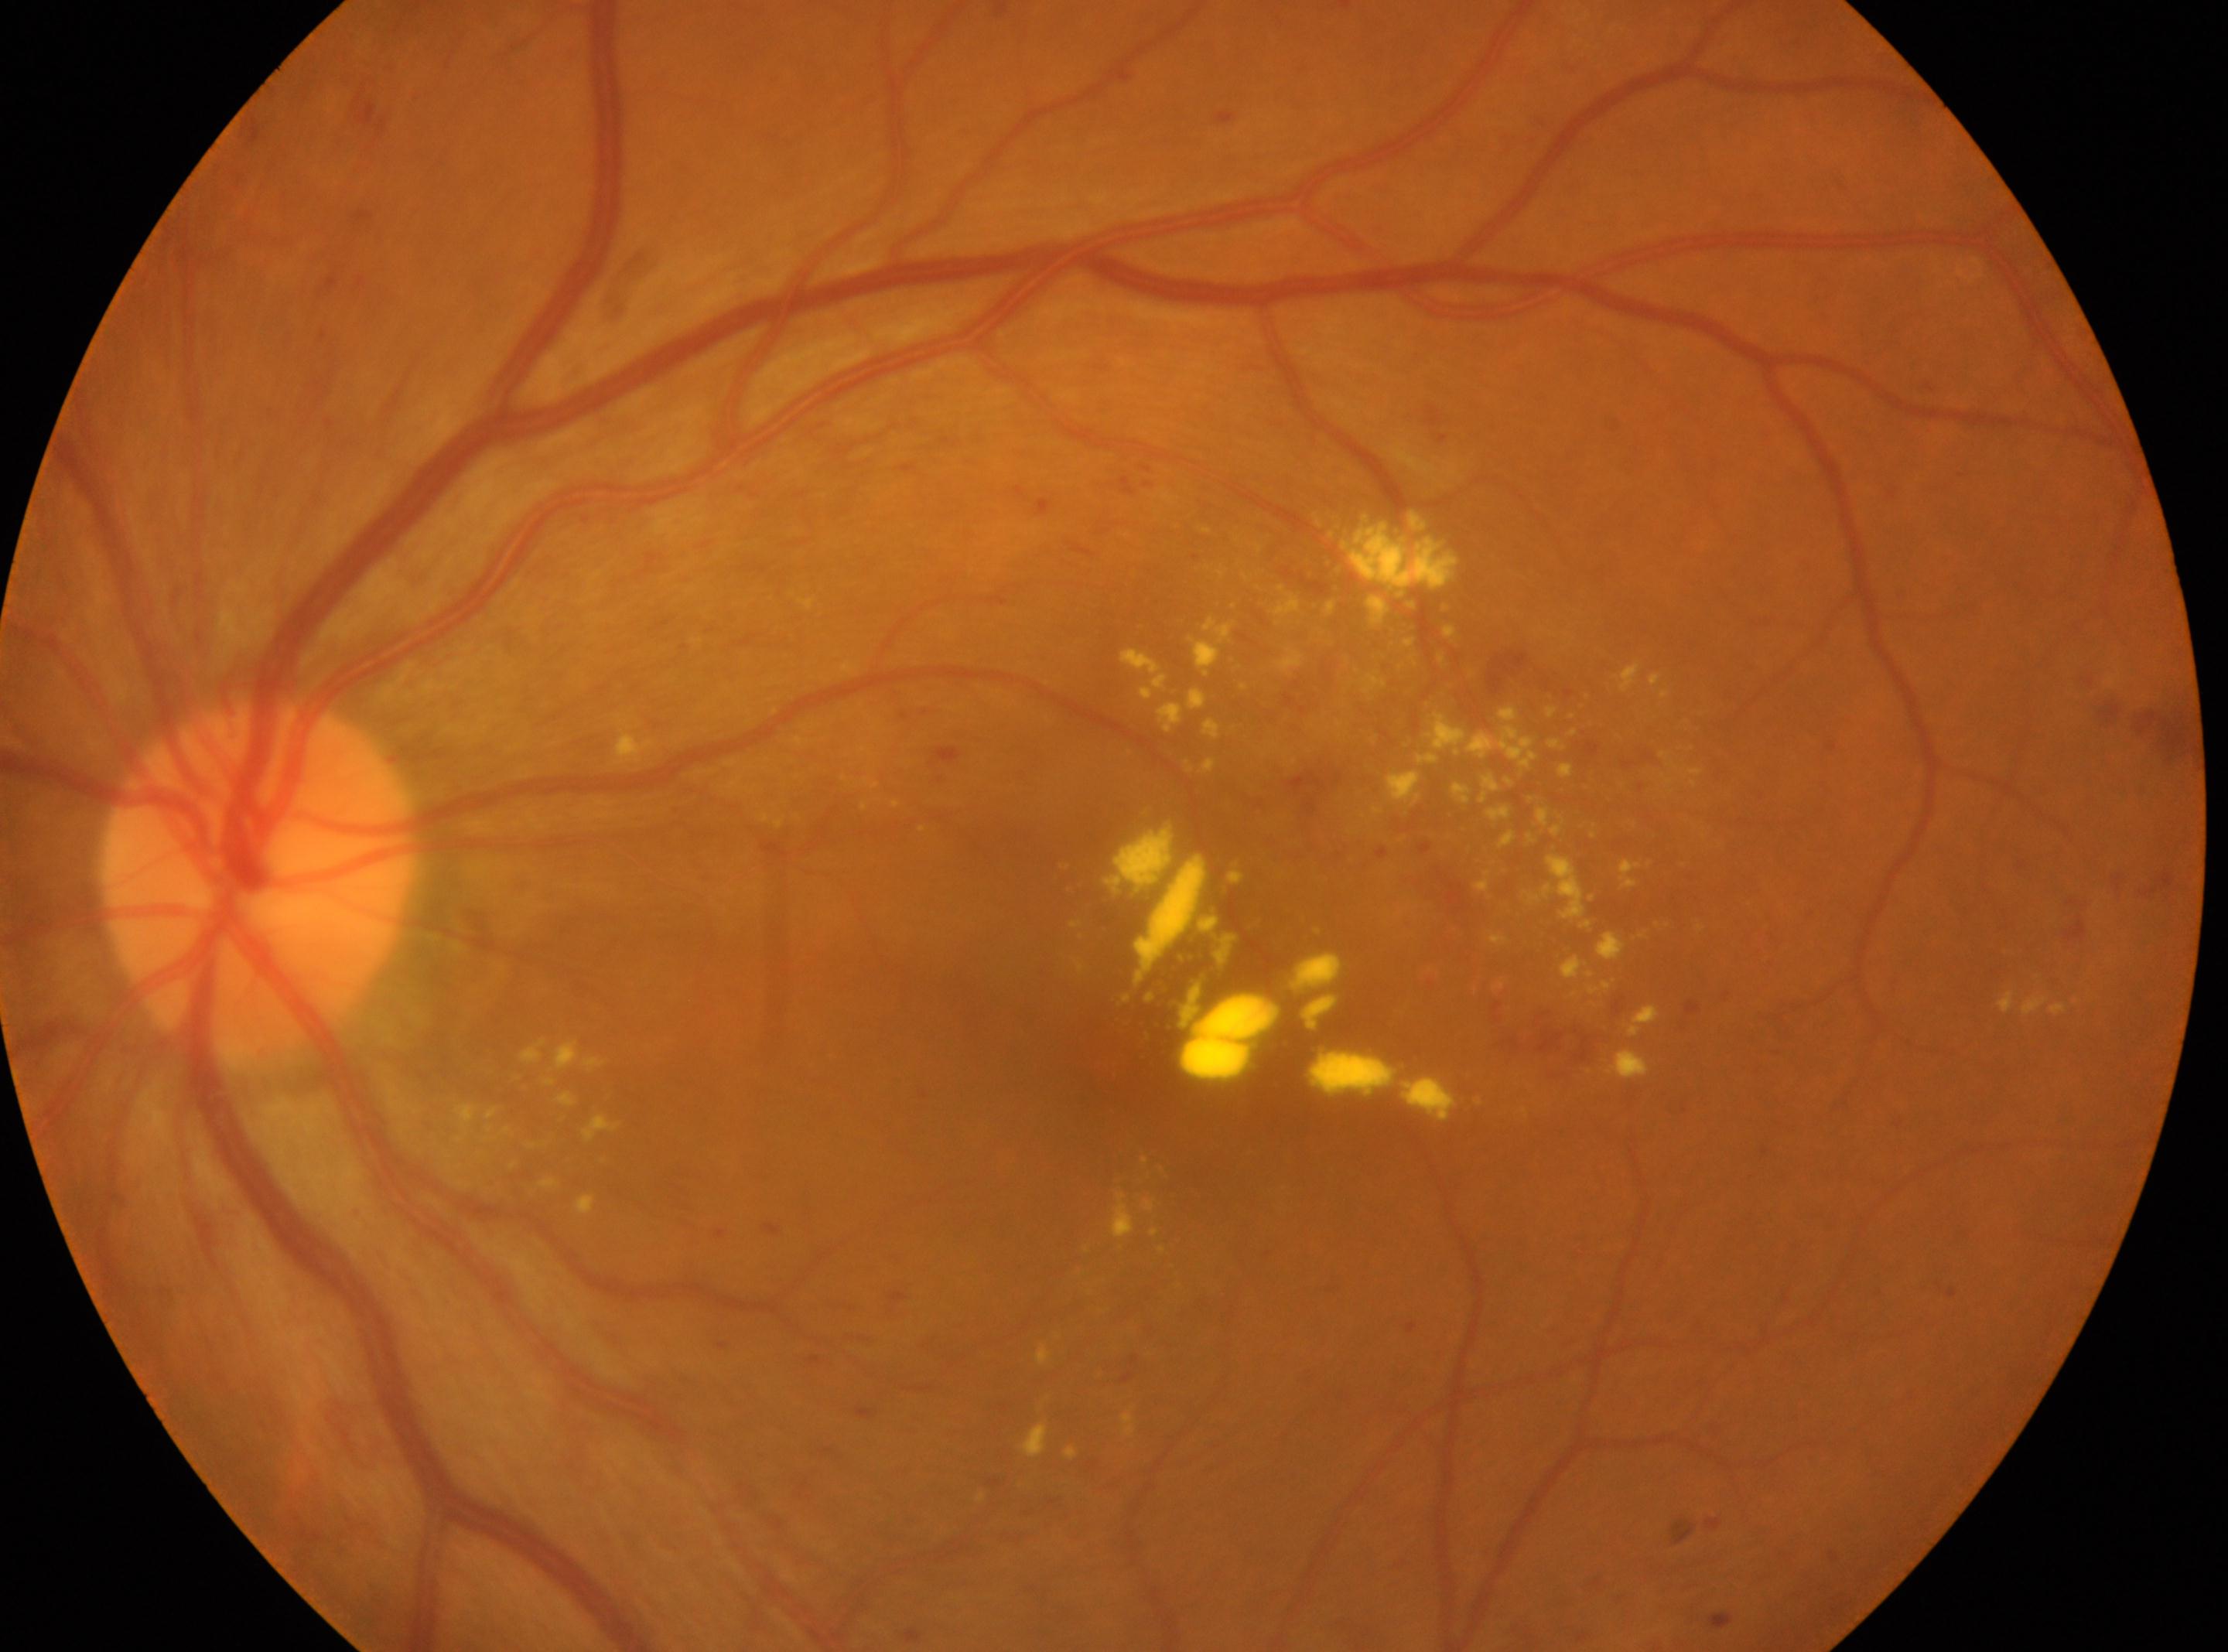 Eye: oculus sinister. Foveal center: [1103, 1061]. The optic disc is at [256, 879]. DR grade: 2 (moderate NPDR).